Color fundus photograph, acquired with a Remidio Fundus on Phone (FOP) camera — 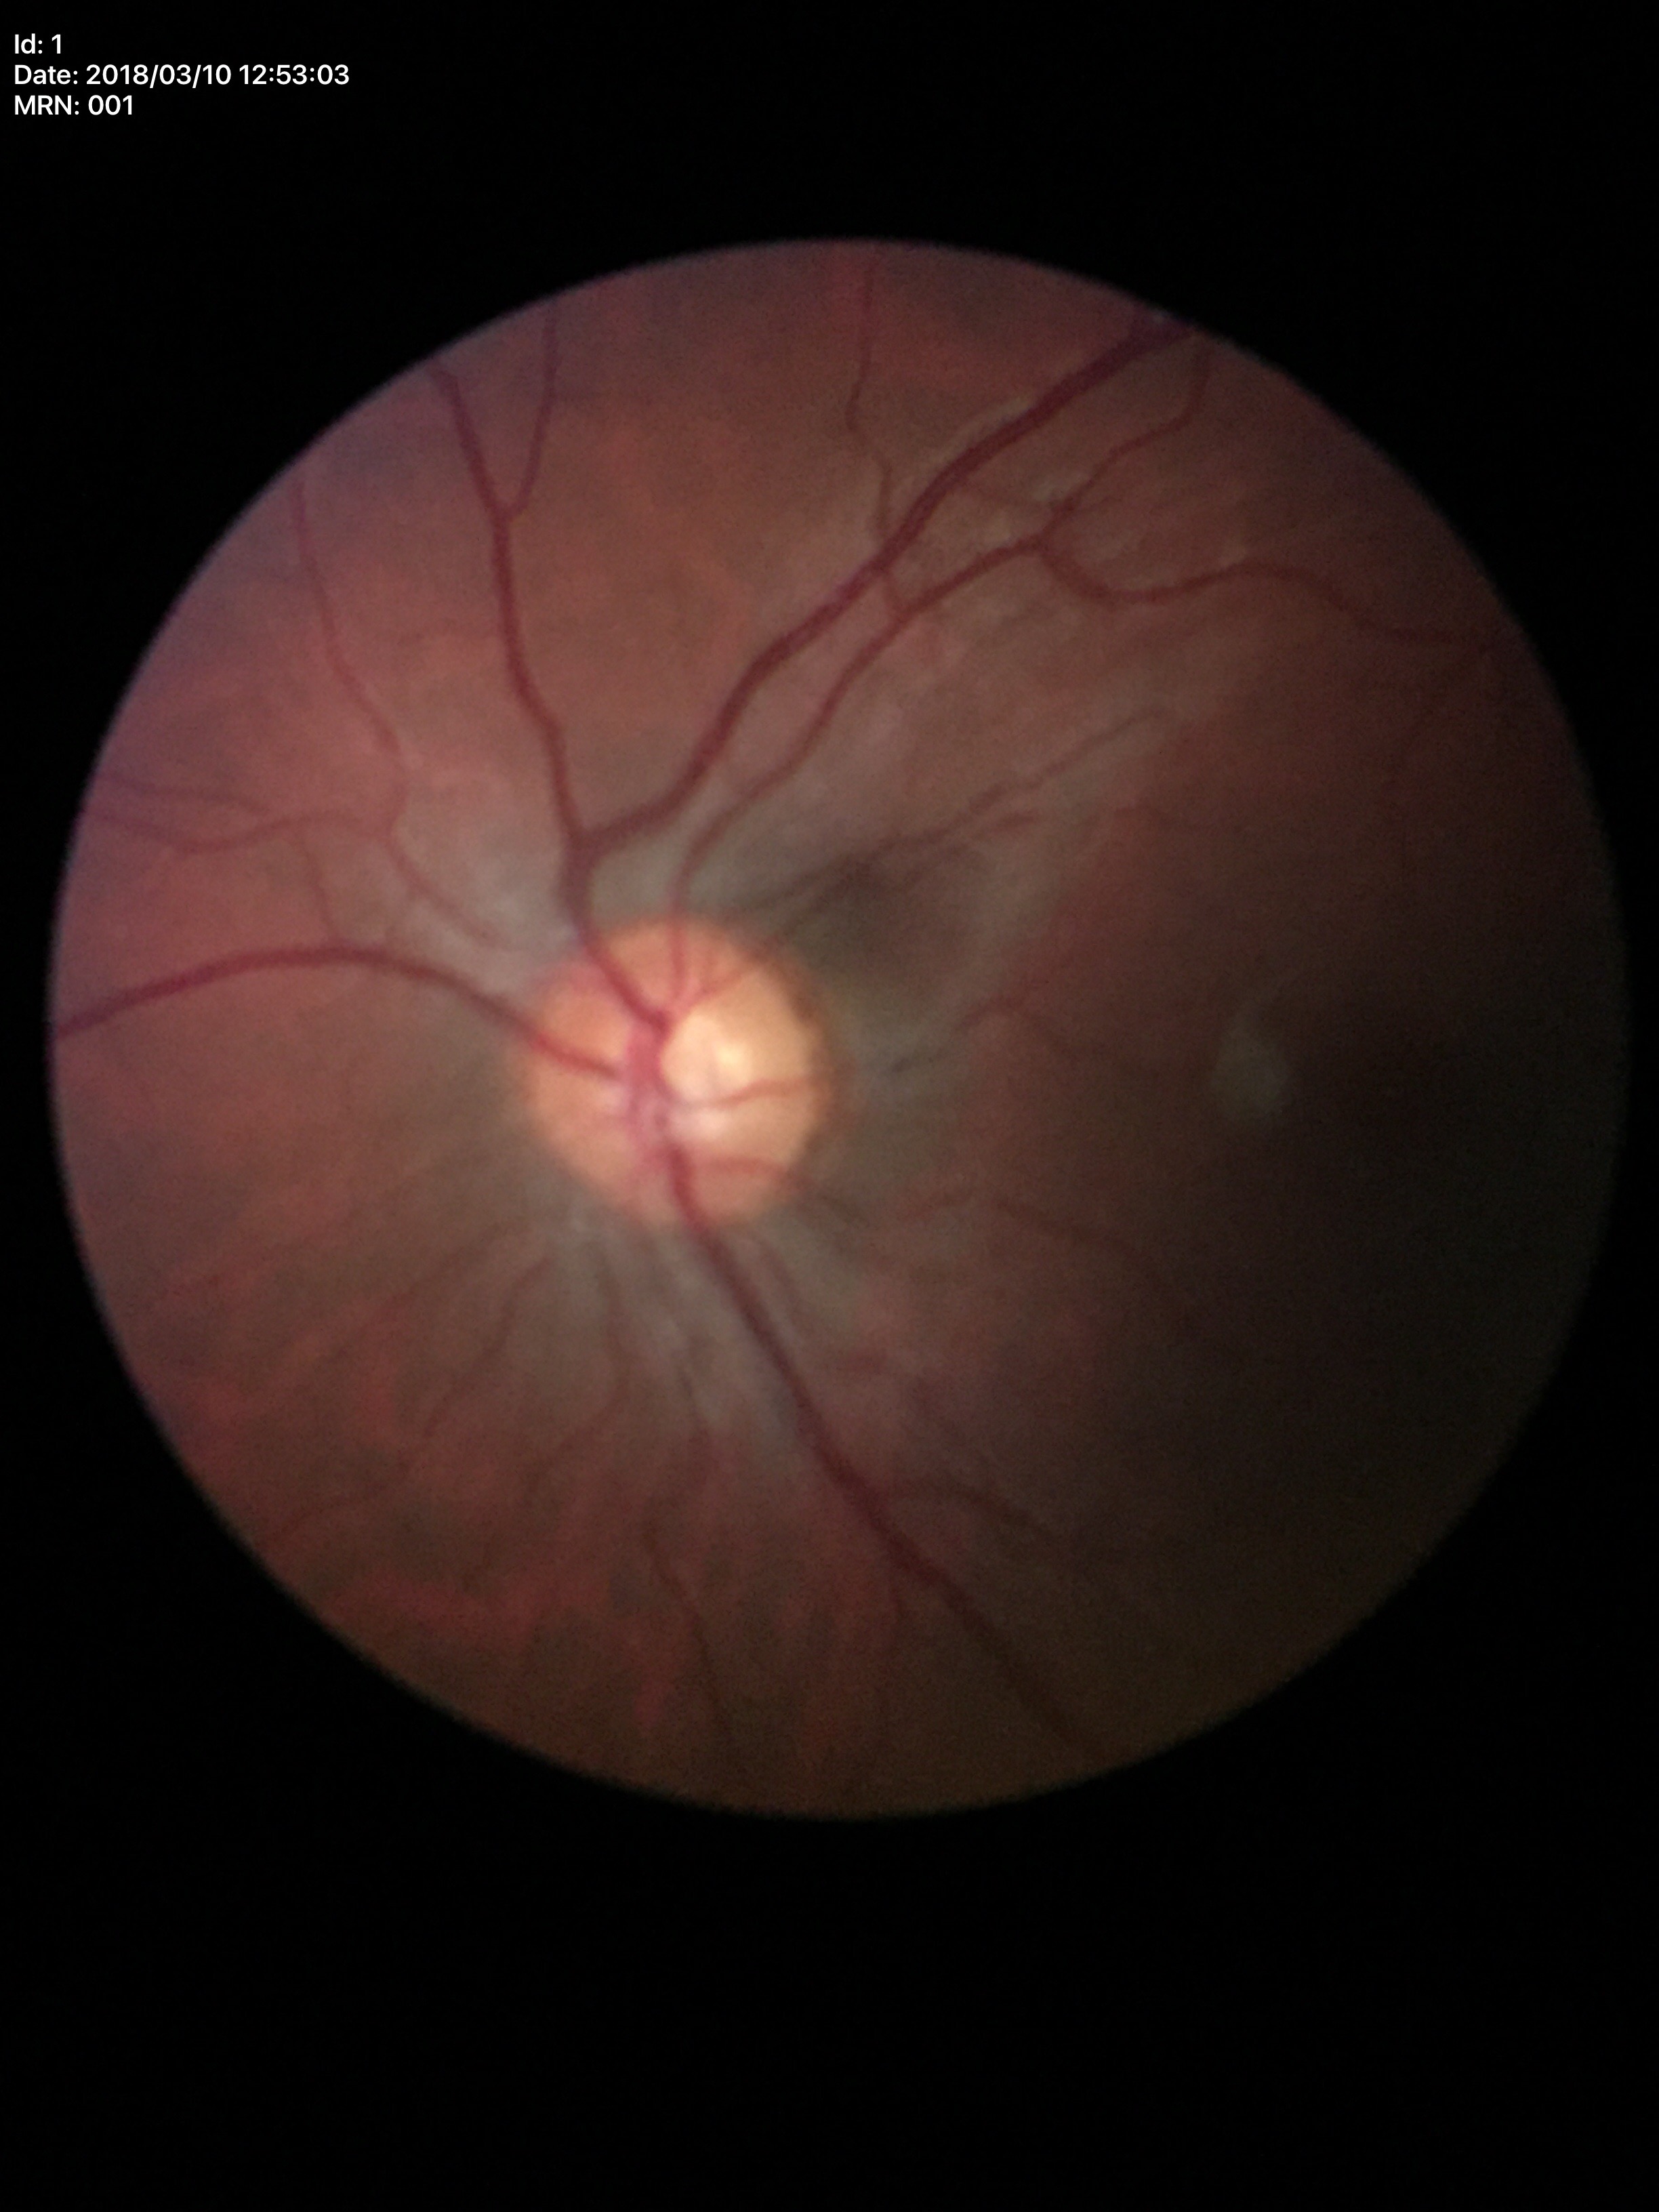
Glaucoma impression: negative (5/5 ophthalmologists in agreement)
vertical cup-to-disc ratio (VCDR): 0.52
area cup-to-disc ratio (ACDR): 0.25